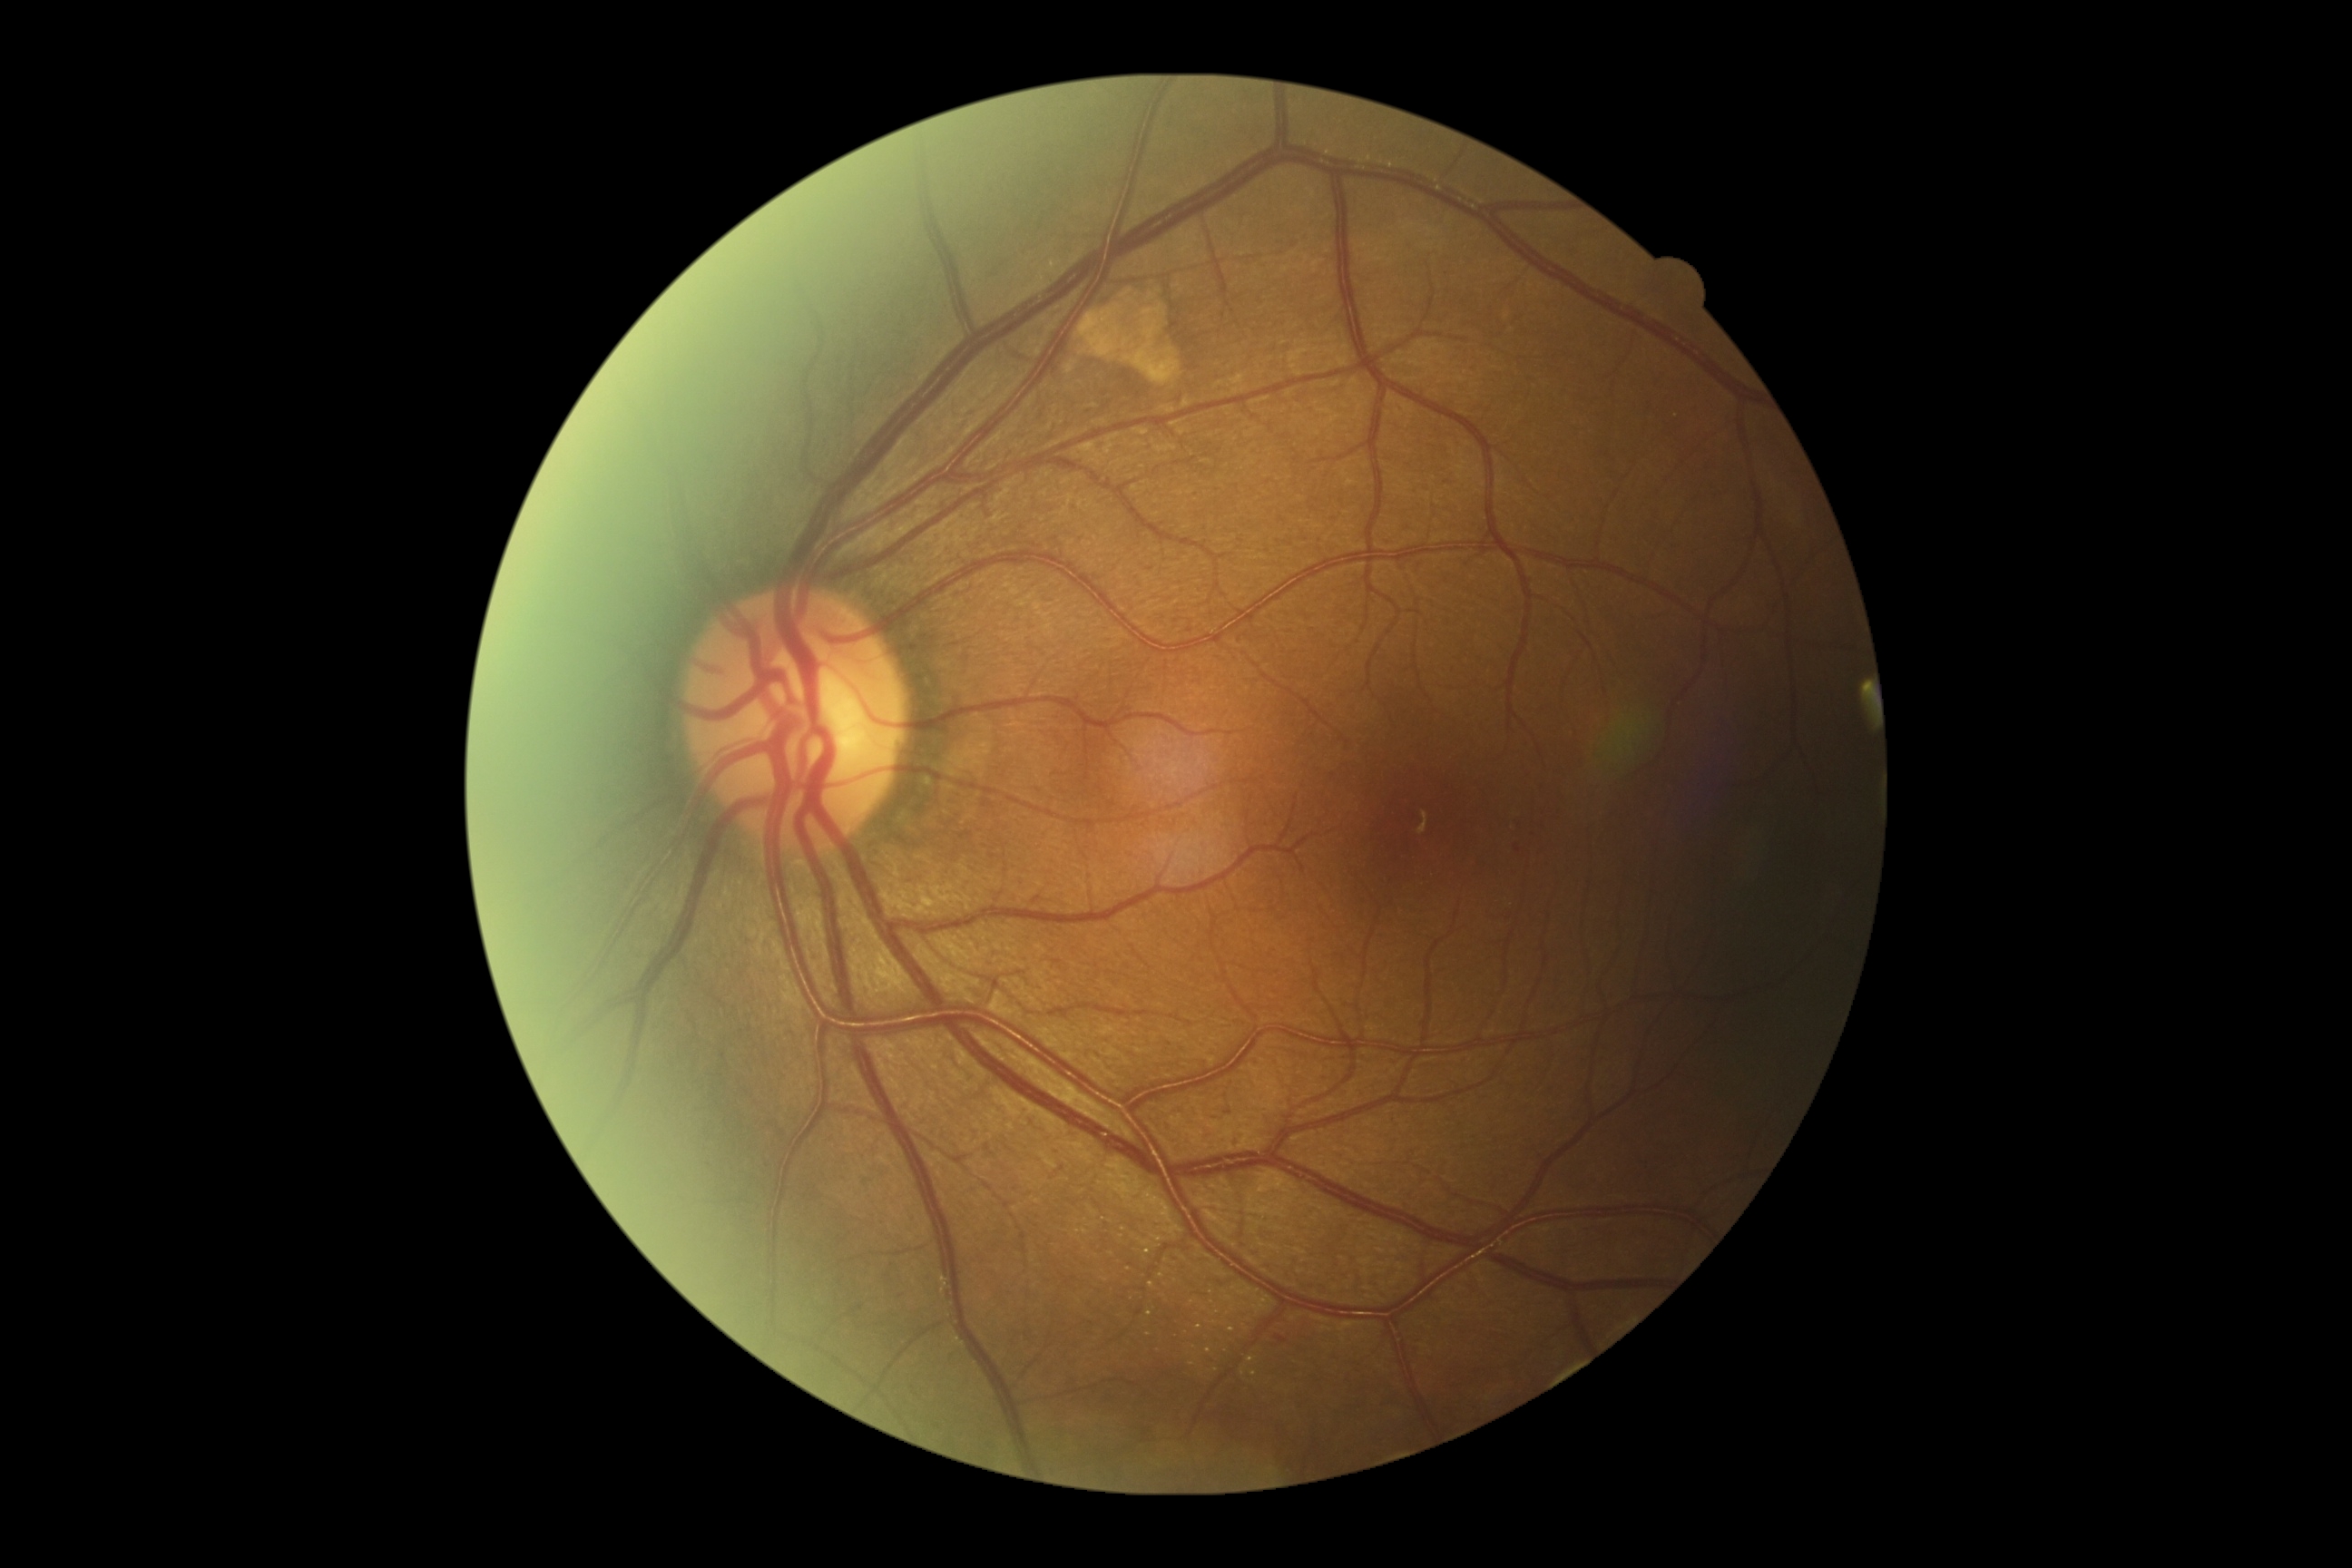

Findings:
– diabetic retinopathy — grade 1 (mild NPDR)